Infant wide-field fundus photograph:
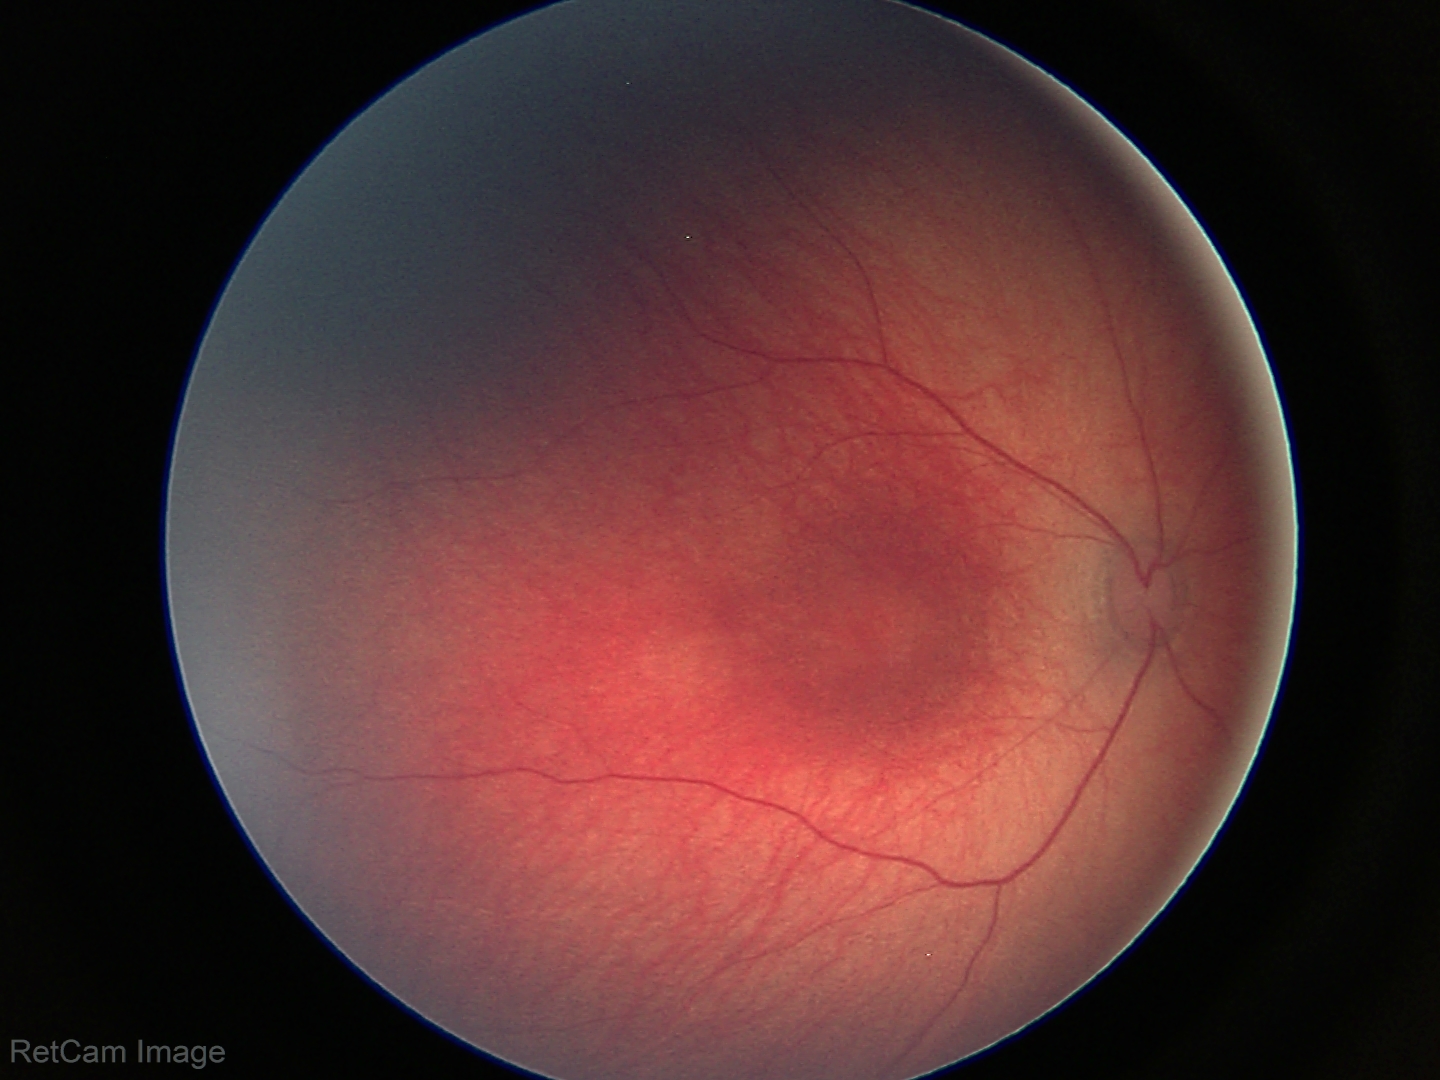 Normal screening examination.